Color fundus photograph centered on the optic disc · cropped from a 35-degree field of view · captured on a Topcon TRC retinal camera.
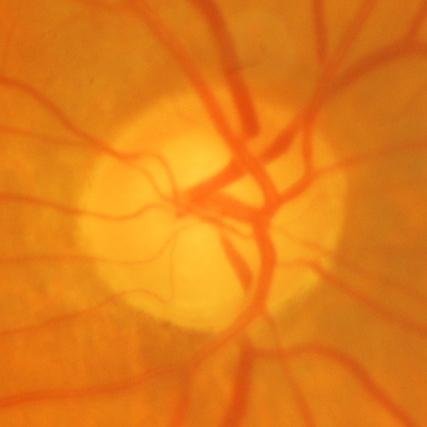 Glaucomatous changes.